Wide-field contact fundus photograph of an infant; 1240 x 1240 pixels; acquired on the Phoenix ICON
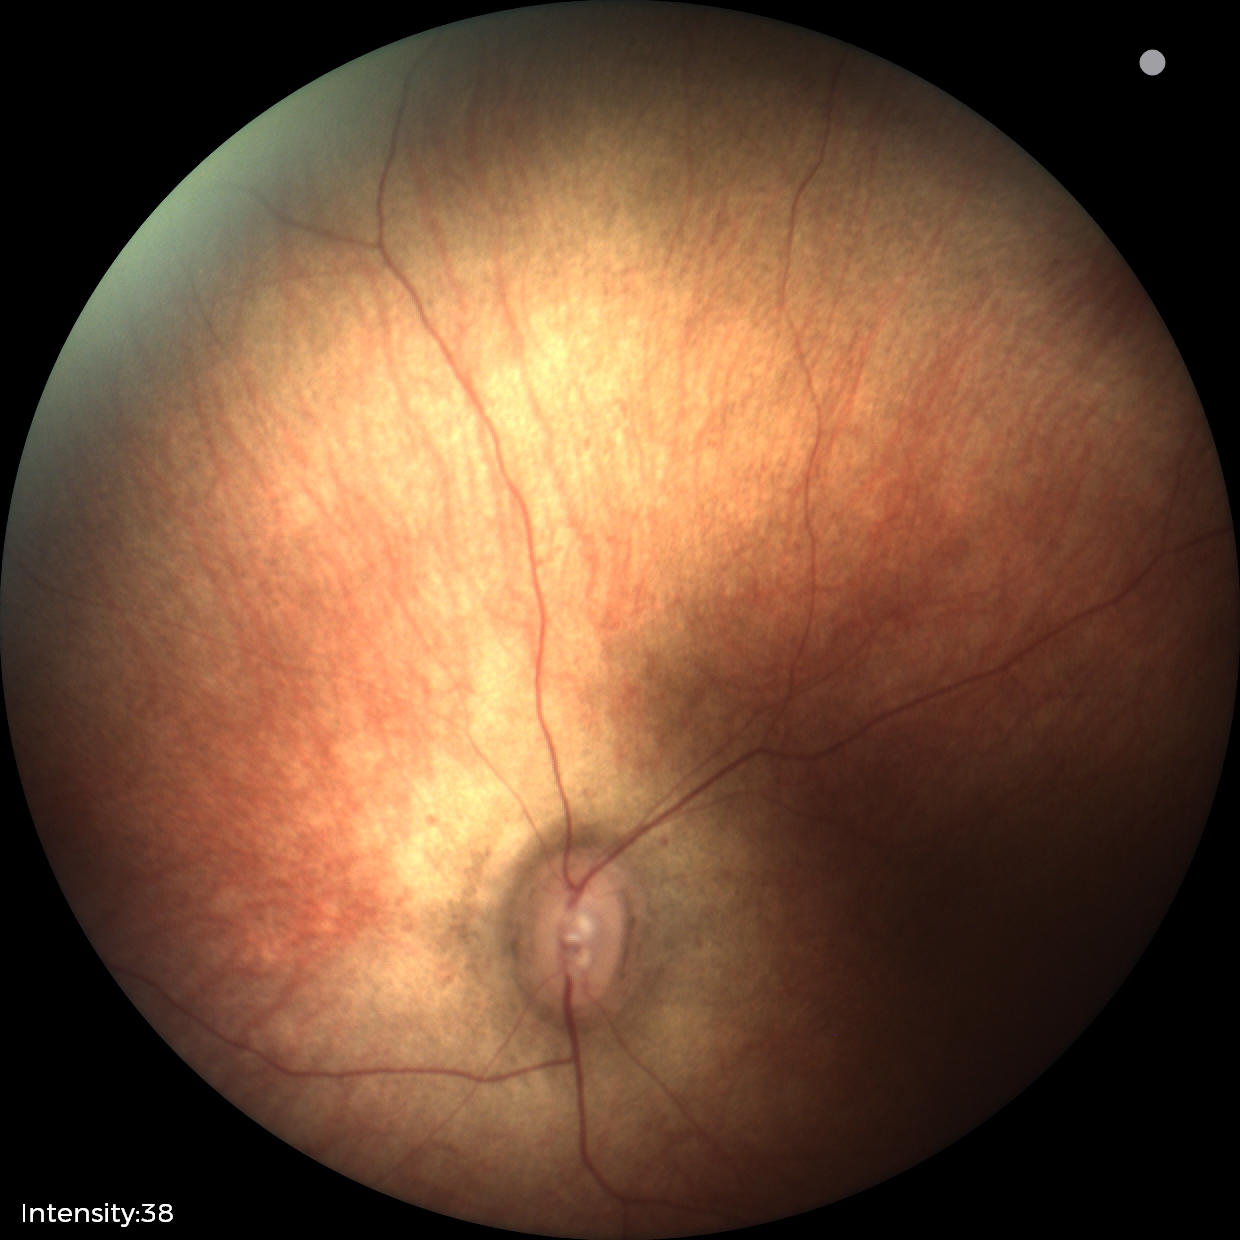

Screening examination diagnosed as physiological.